Image size 2212x1661 · non-mydriatic acquisition — 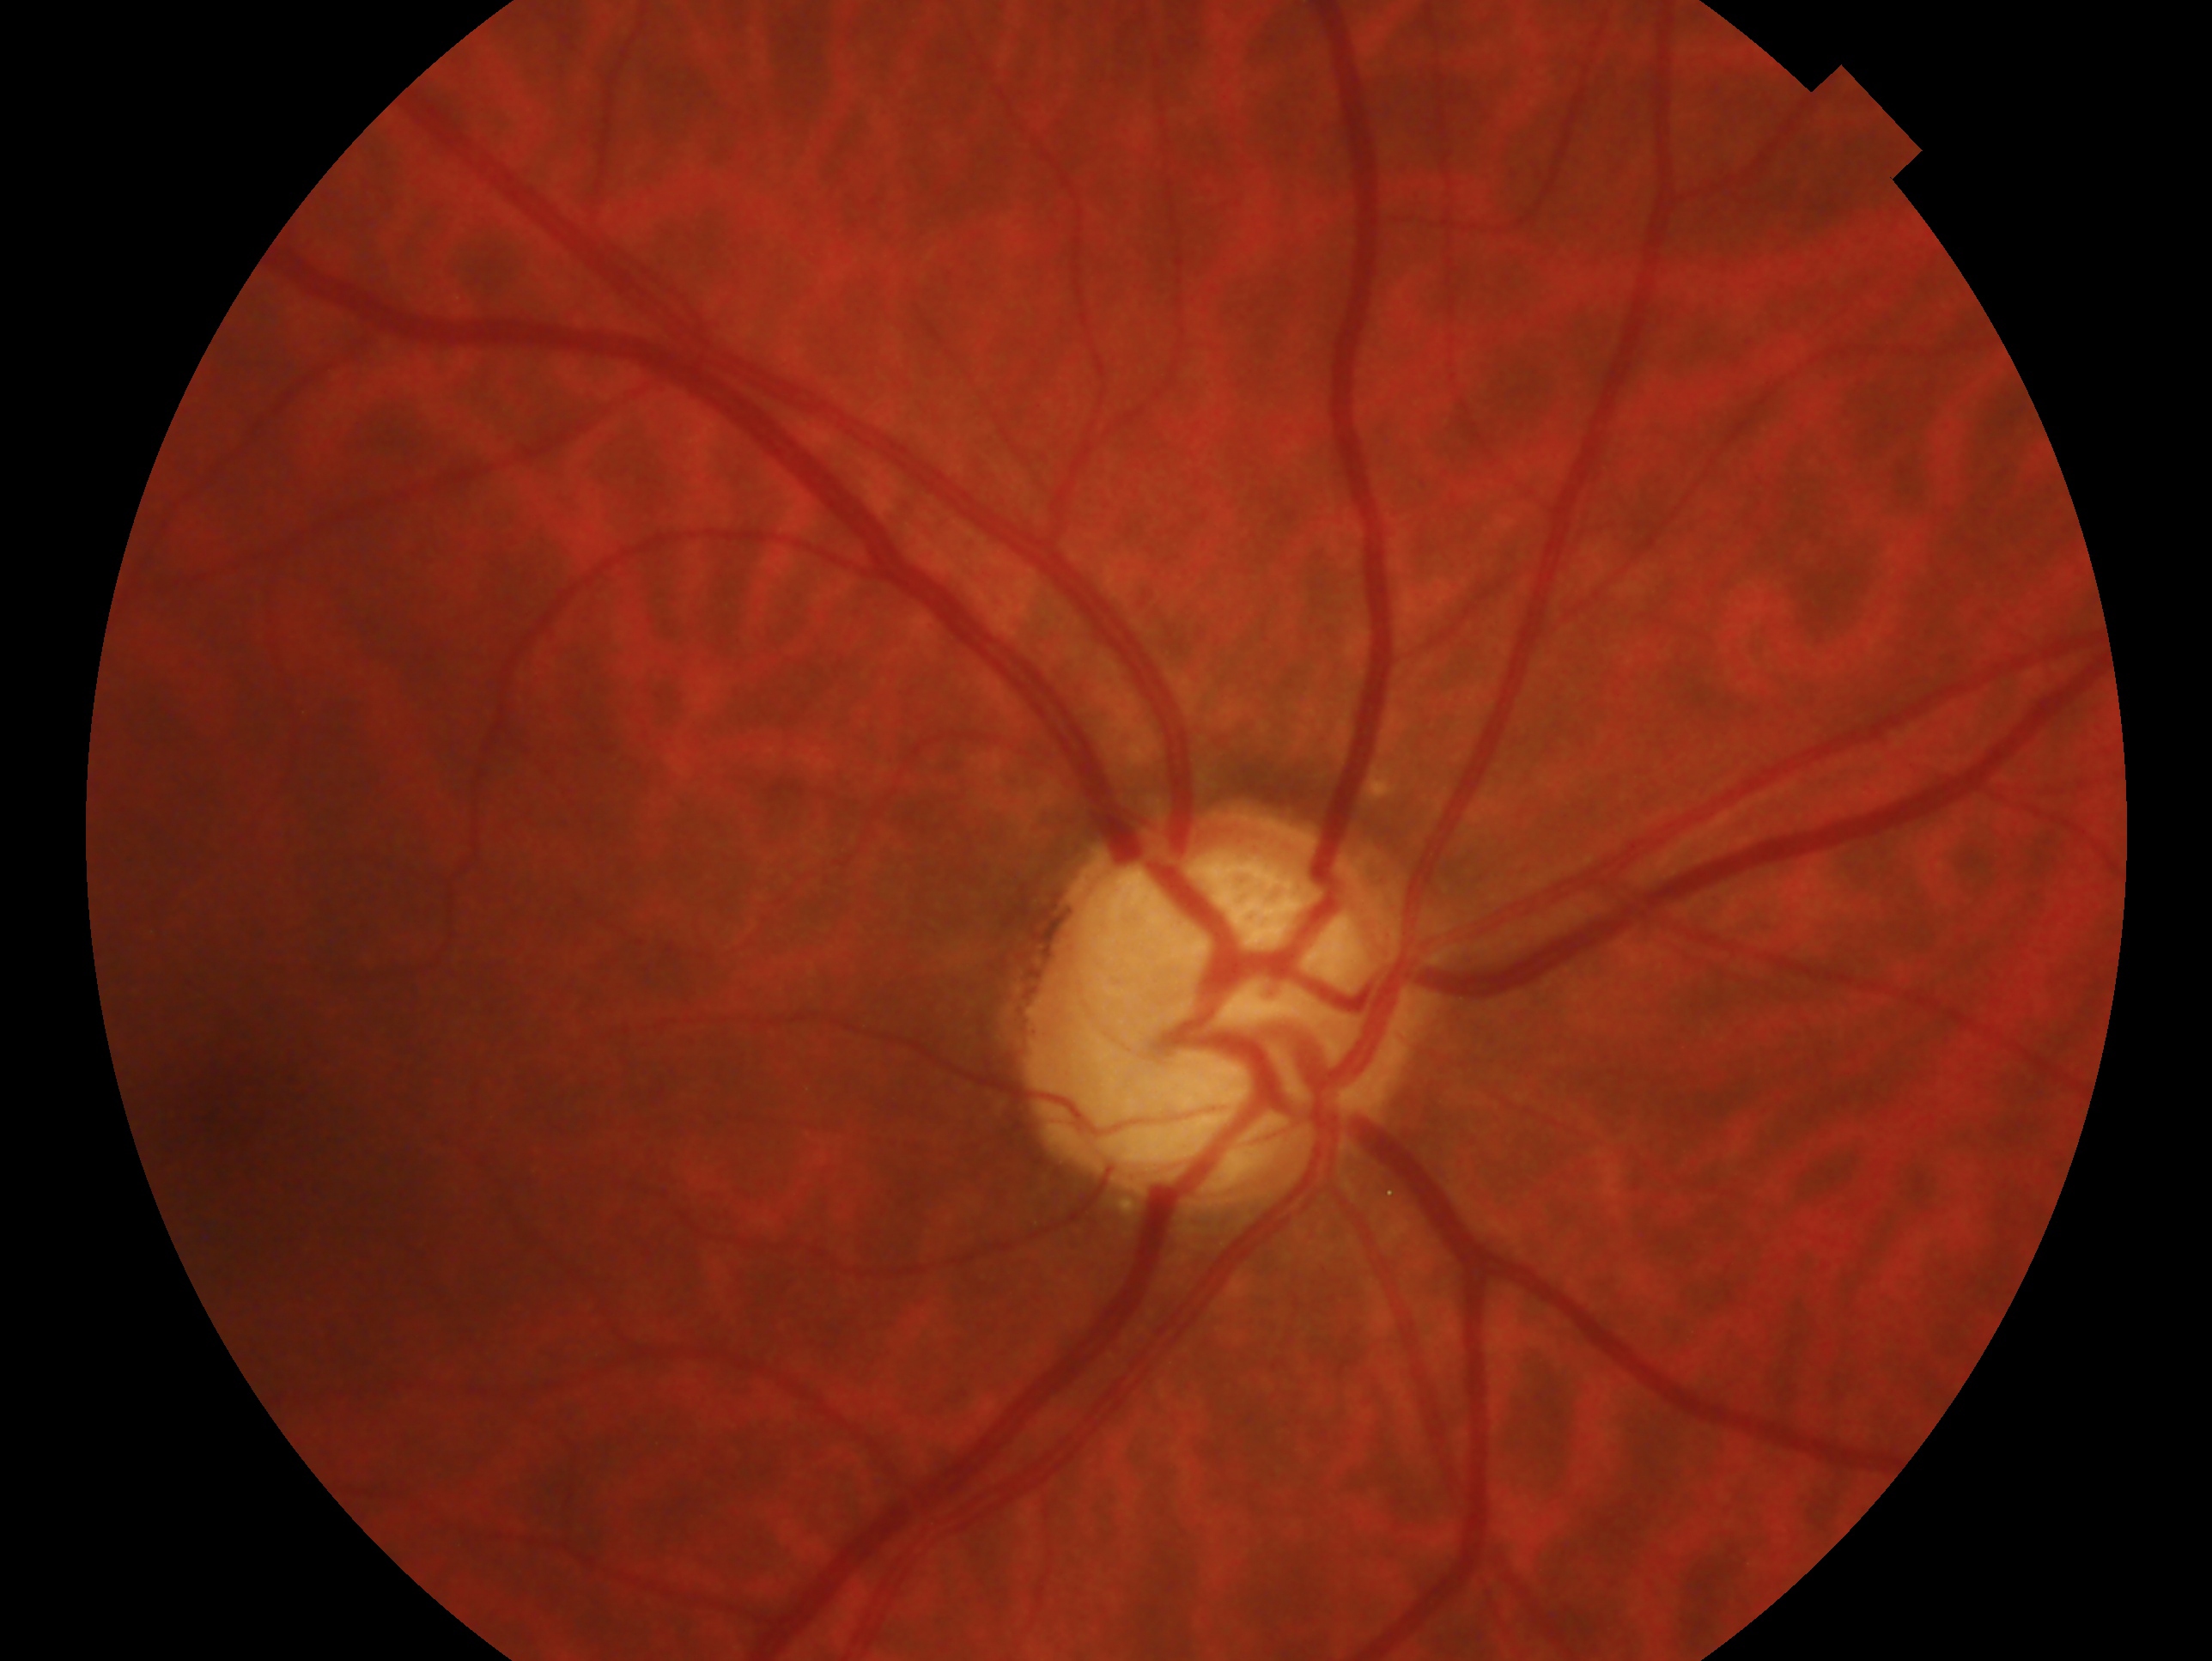

Glaucoma assessment: consistent with glaucoma. Eye: OD.